DR severity per modified Davis staging.
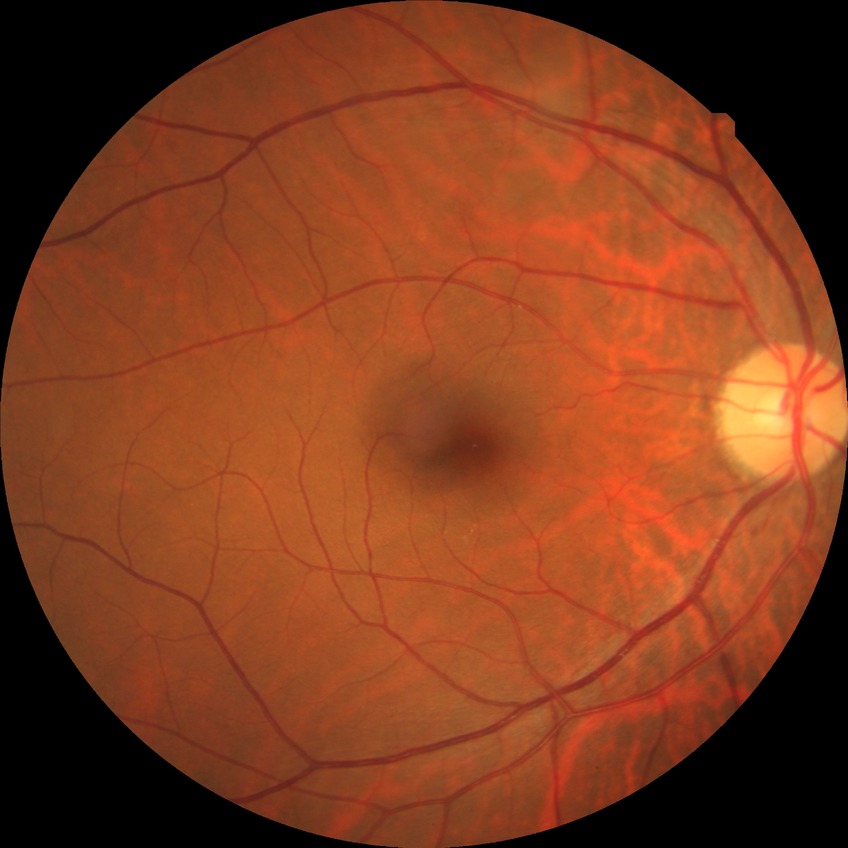 Diabetic retinopathy grade: no diabetic retinopathy.